Camera: Phoenix ICON (100° FOV). Pediatric wide-field fundus photograph. 1240 by 1240 pixels:
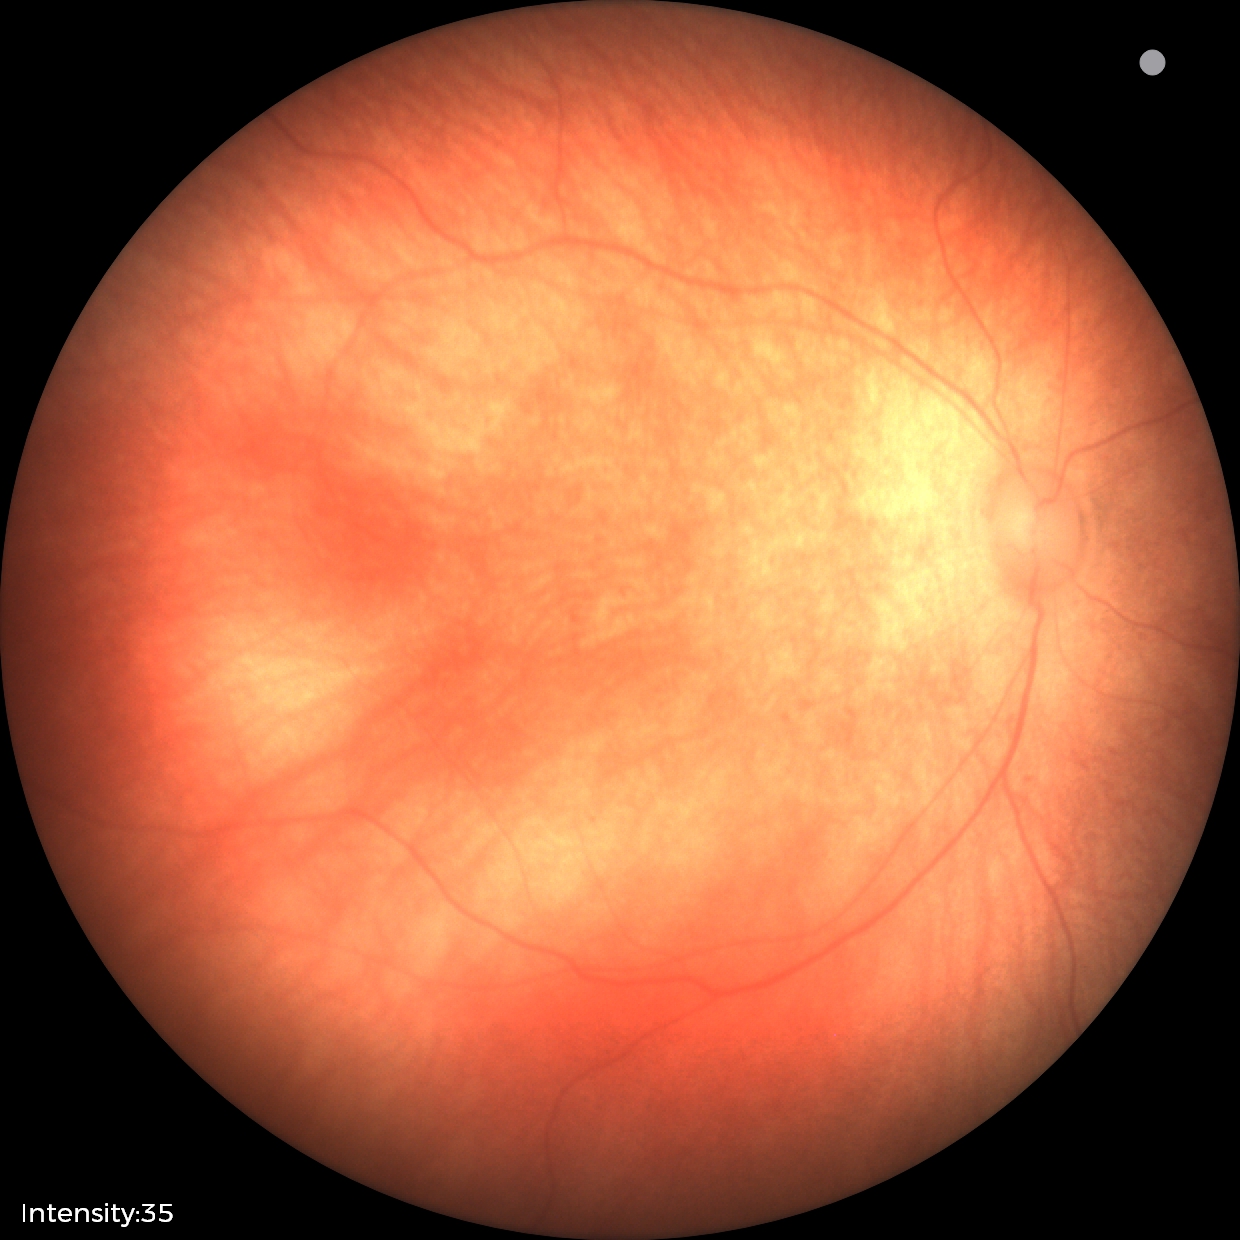
Physiological retinal appearance for postconceptual age.